Camera: Phoenix ICON (100° FOV) · wide-field fundus photograph from neonatal ROP screening · 1240x1240.
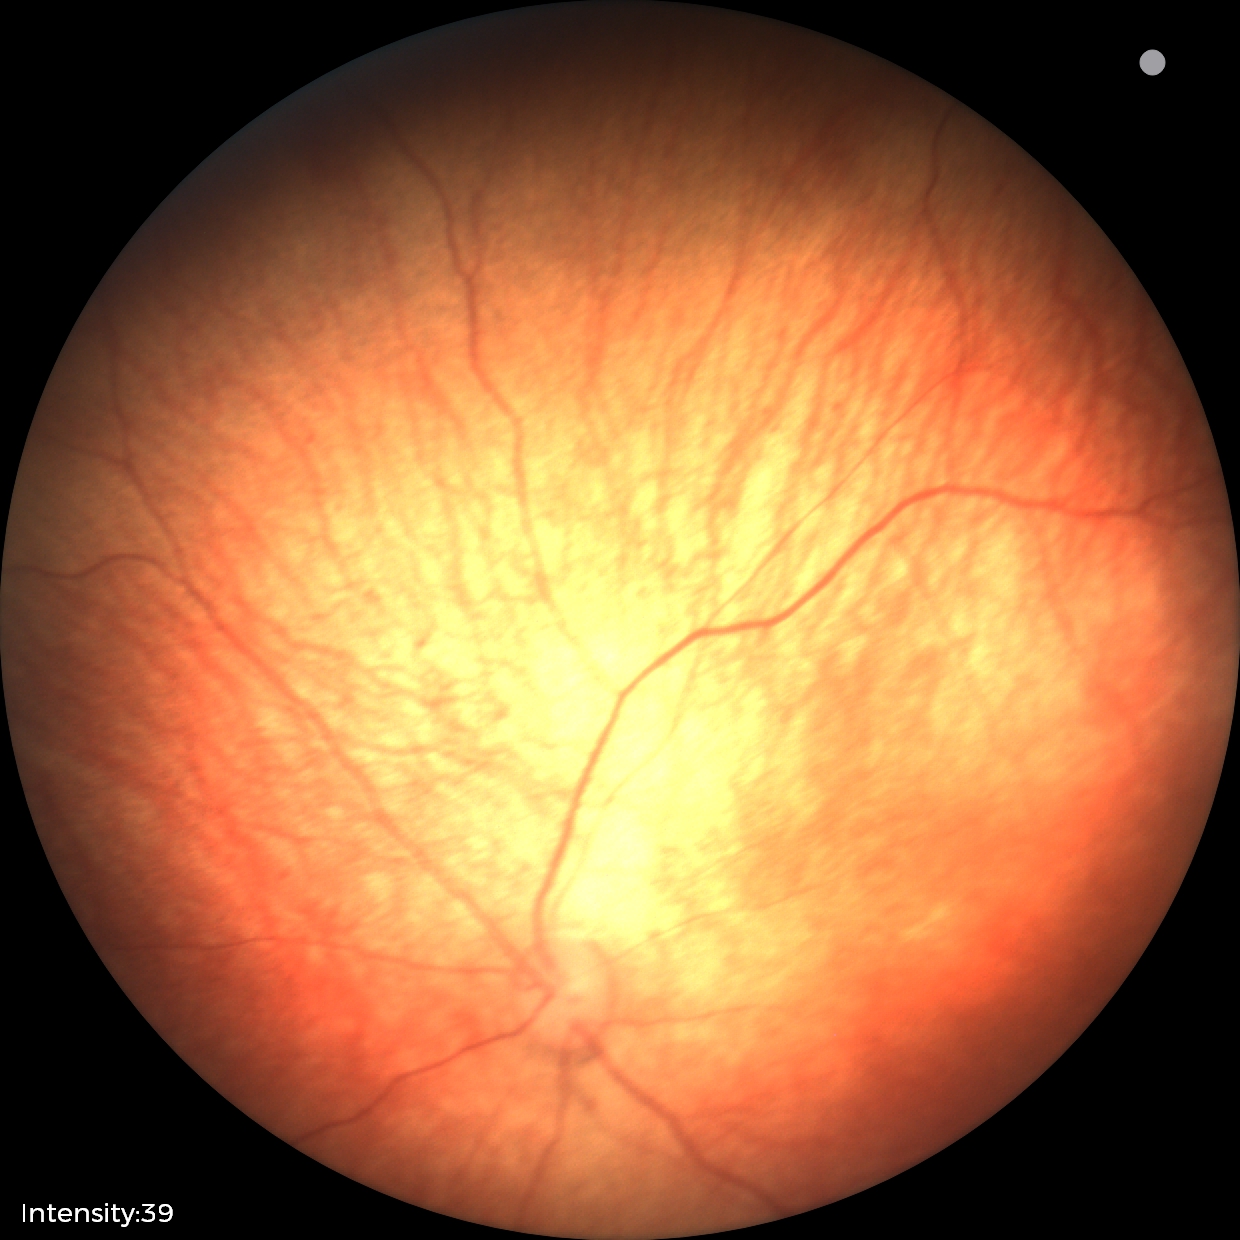

Normal screening examination.